848 x 848 pixels; modified Davis classification — 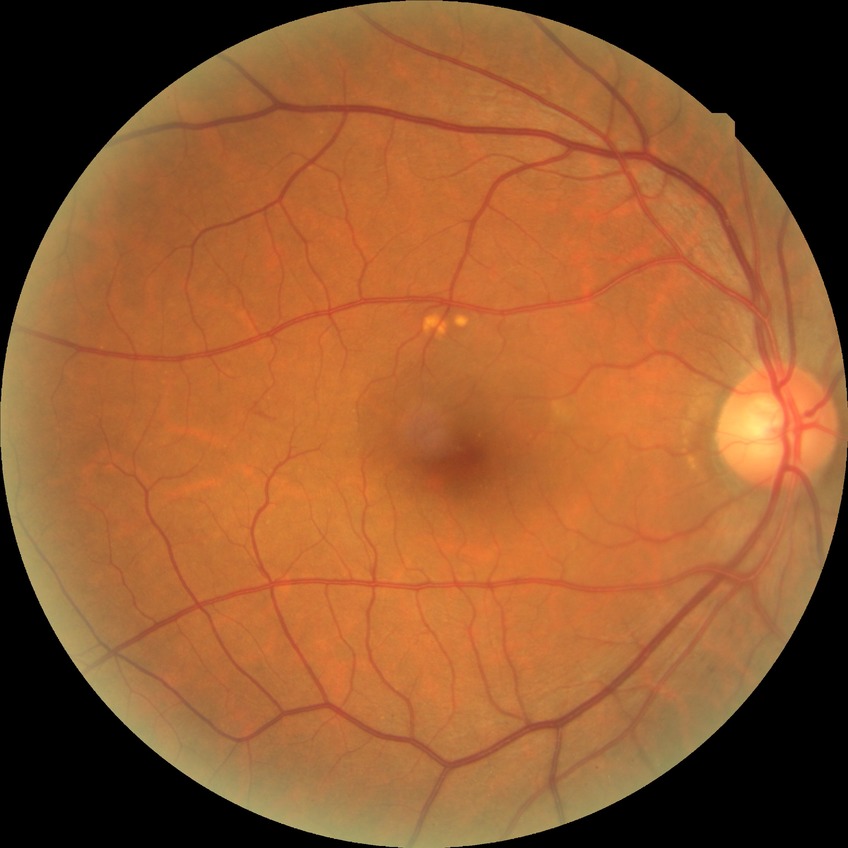 DR stage: NDR.